Wide-field fundus photograph of an infant:
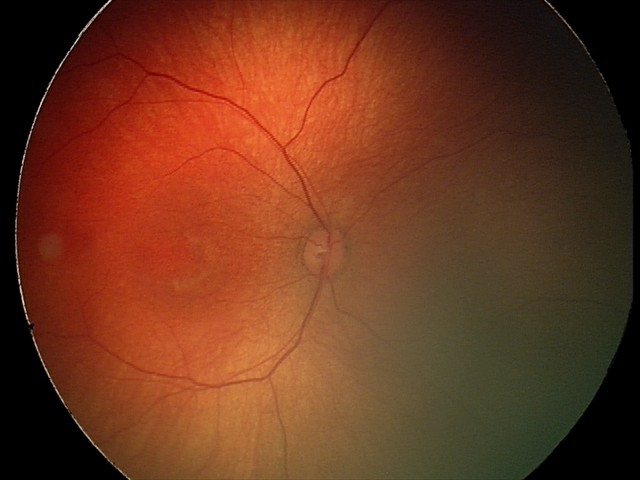 No retinal pathology identified on screening.